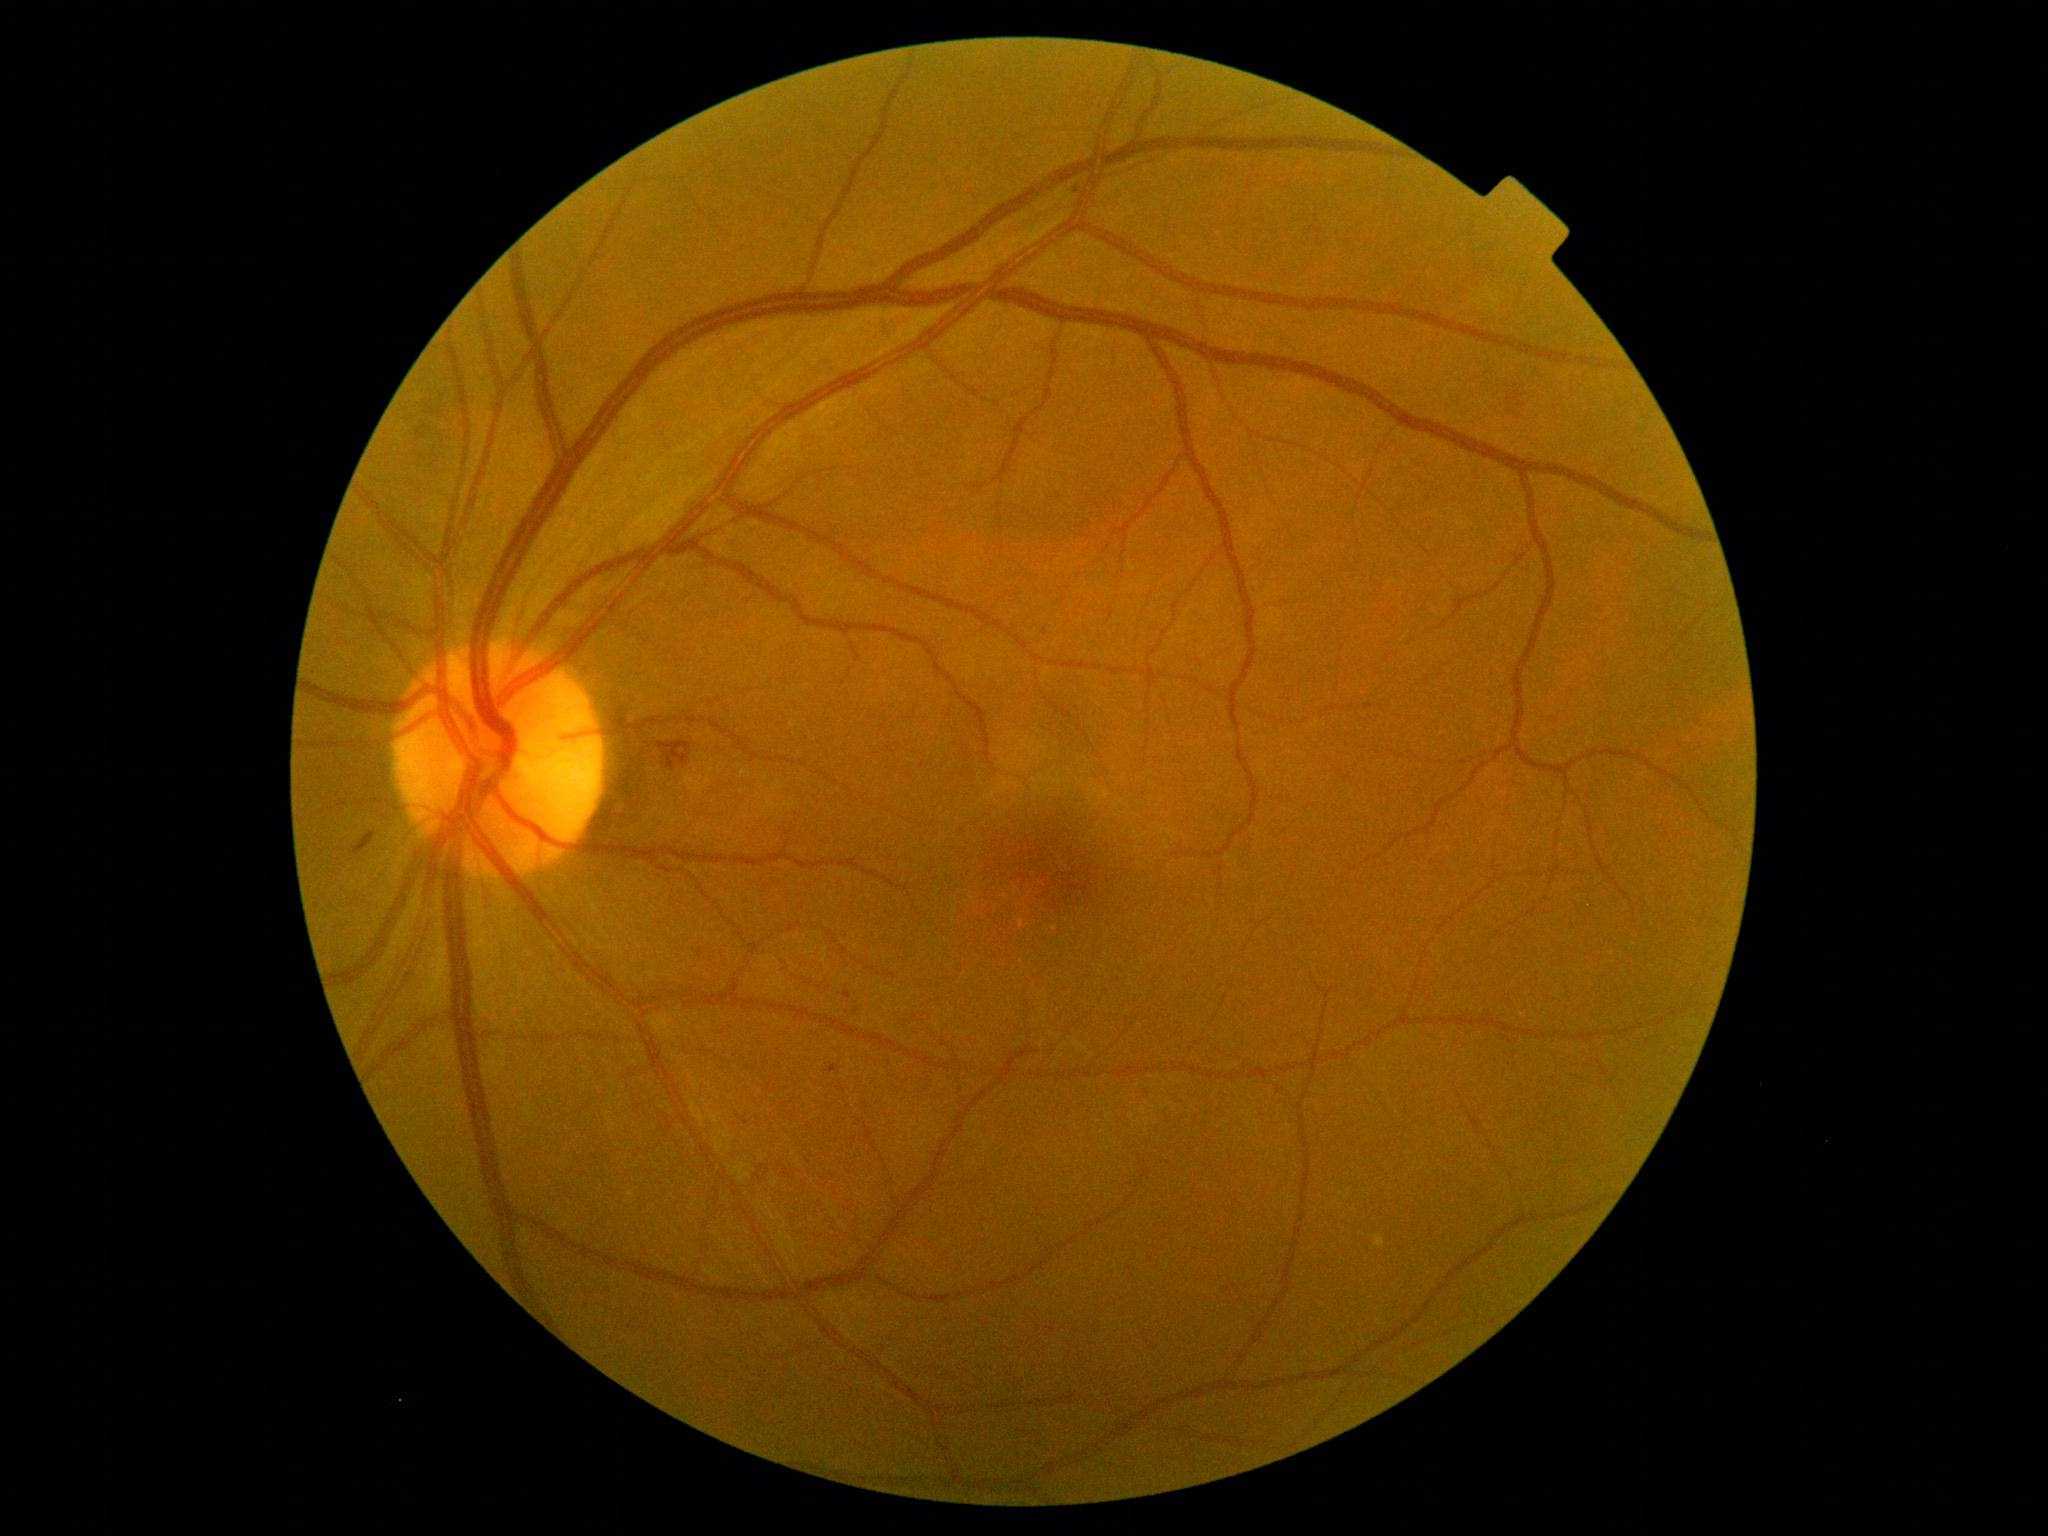

<lesions>
  <dr_grade>2</dr_grade>
  <ex />
  <ma>bbox(828, 1064, 842, 1074)</ma>
  <ma_small>Point(848, 995)</ma_small>
  <he>bbox(356, 831, 374, 851); bbox(1508, 391, 1526, 408)</he>
  <se />
</lesions>